45 degree fundus photograph. Graded on the modified Davis scale. Posterior pole photograph
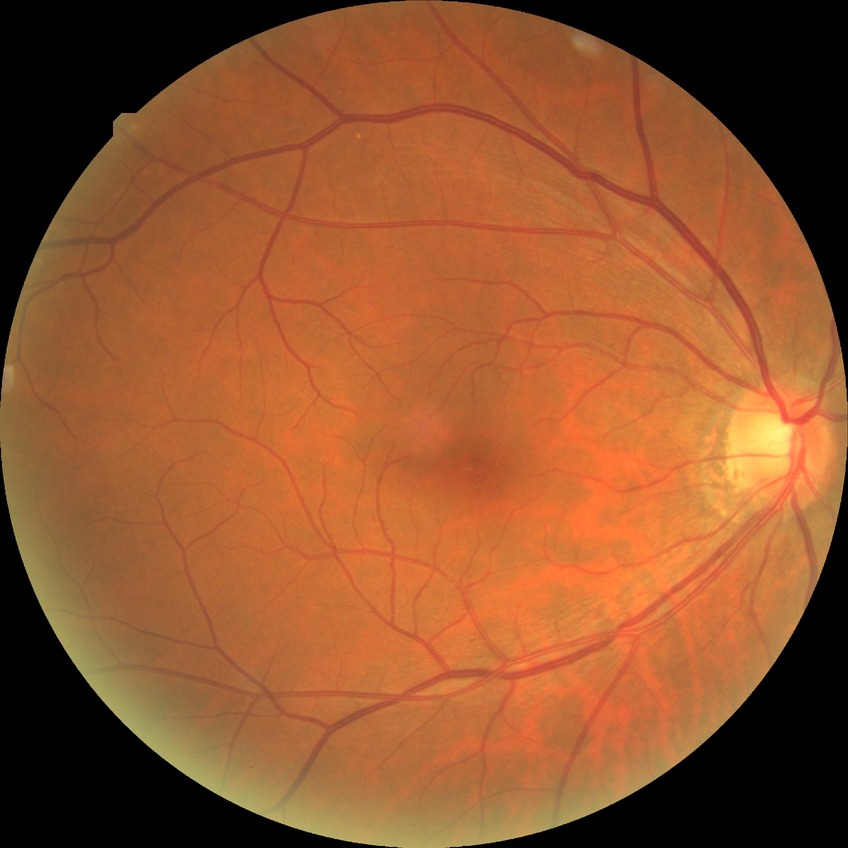
Diabetic retinopathy grade is no diabetic retinopathy.